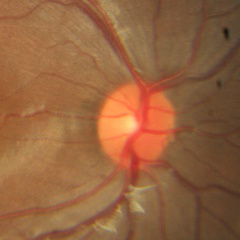

Demonstrates no evidence of glaucoma.